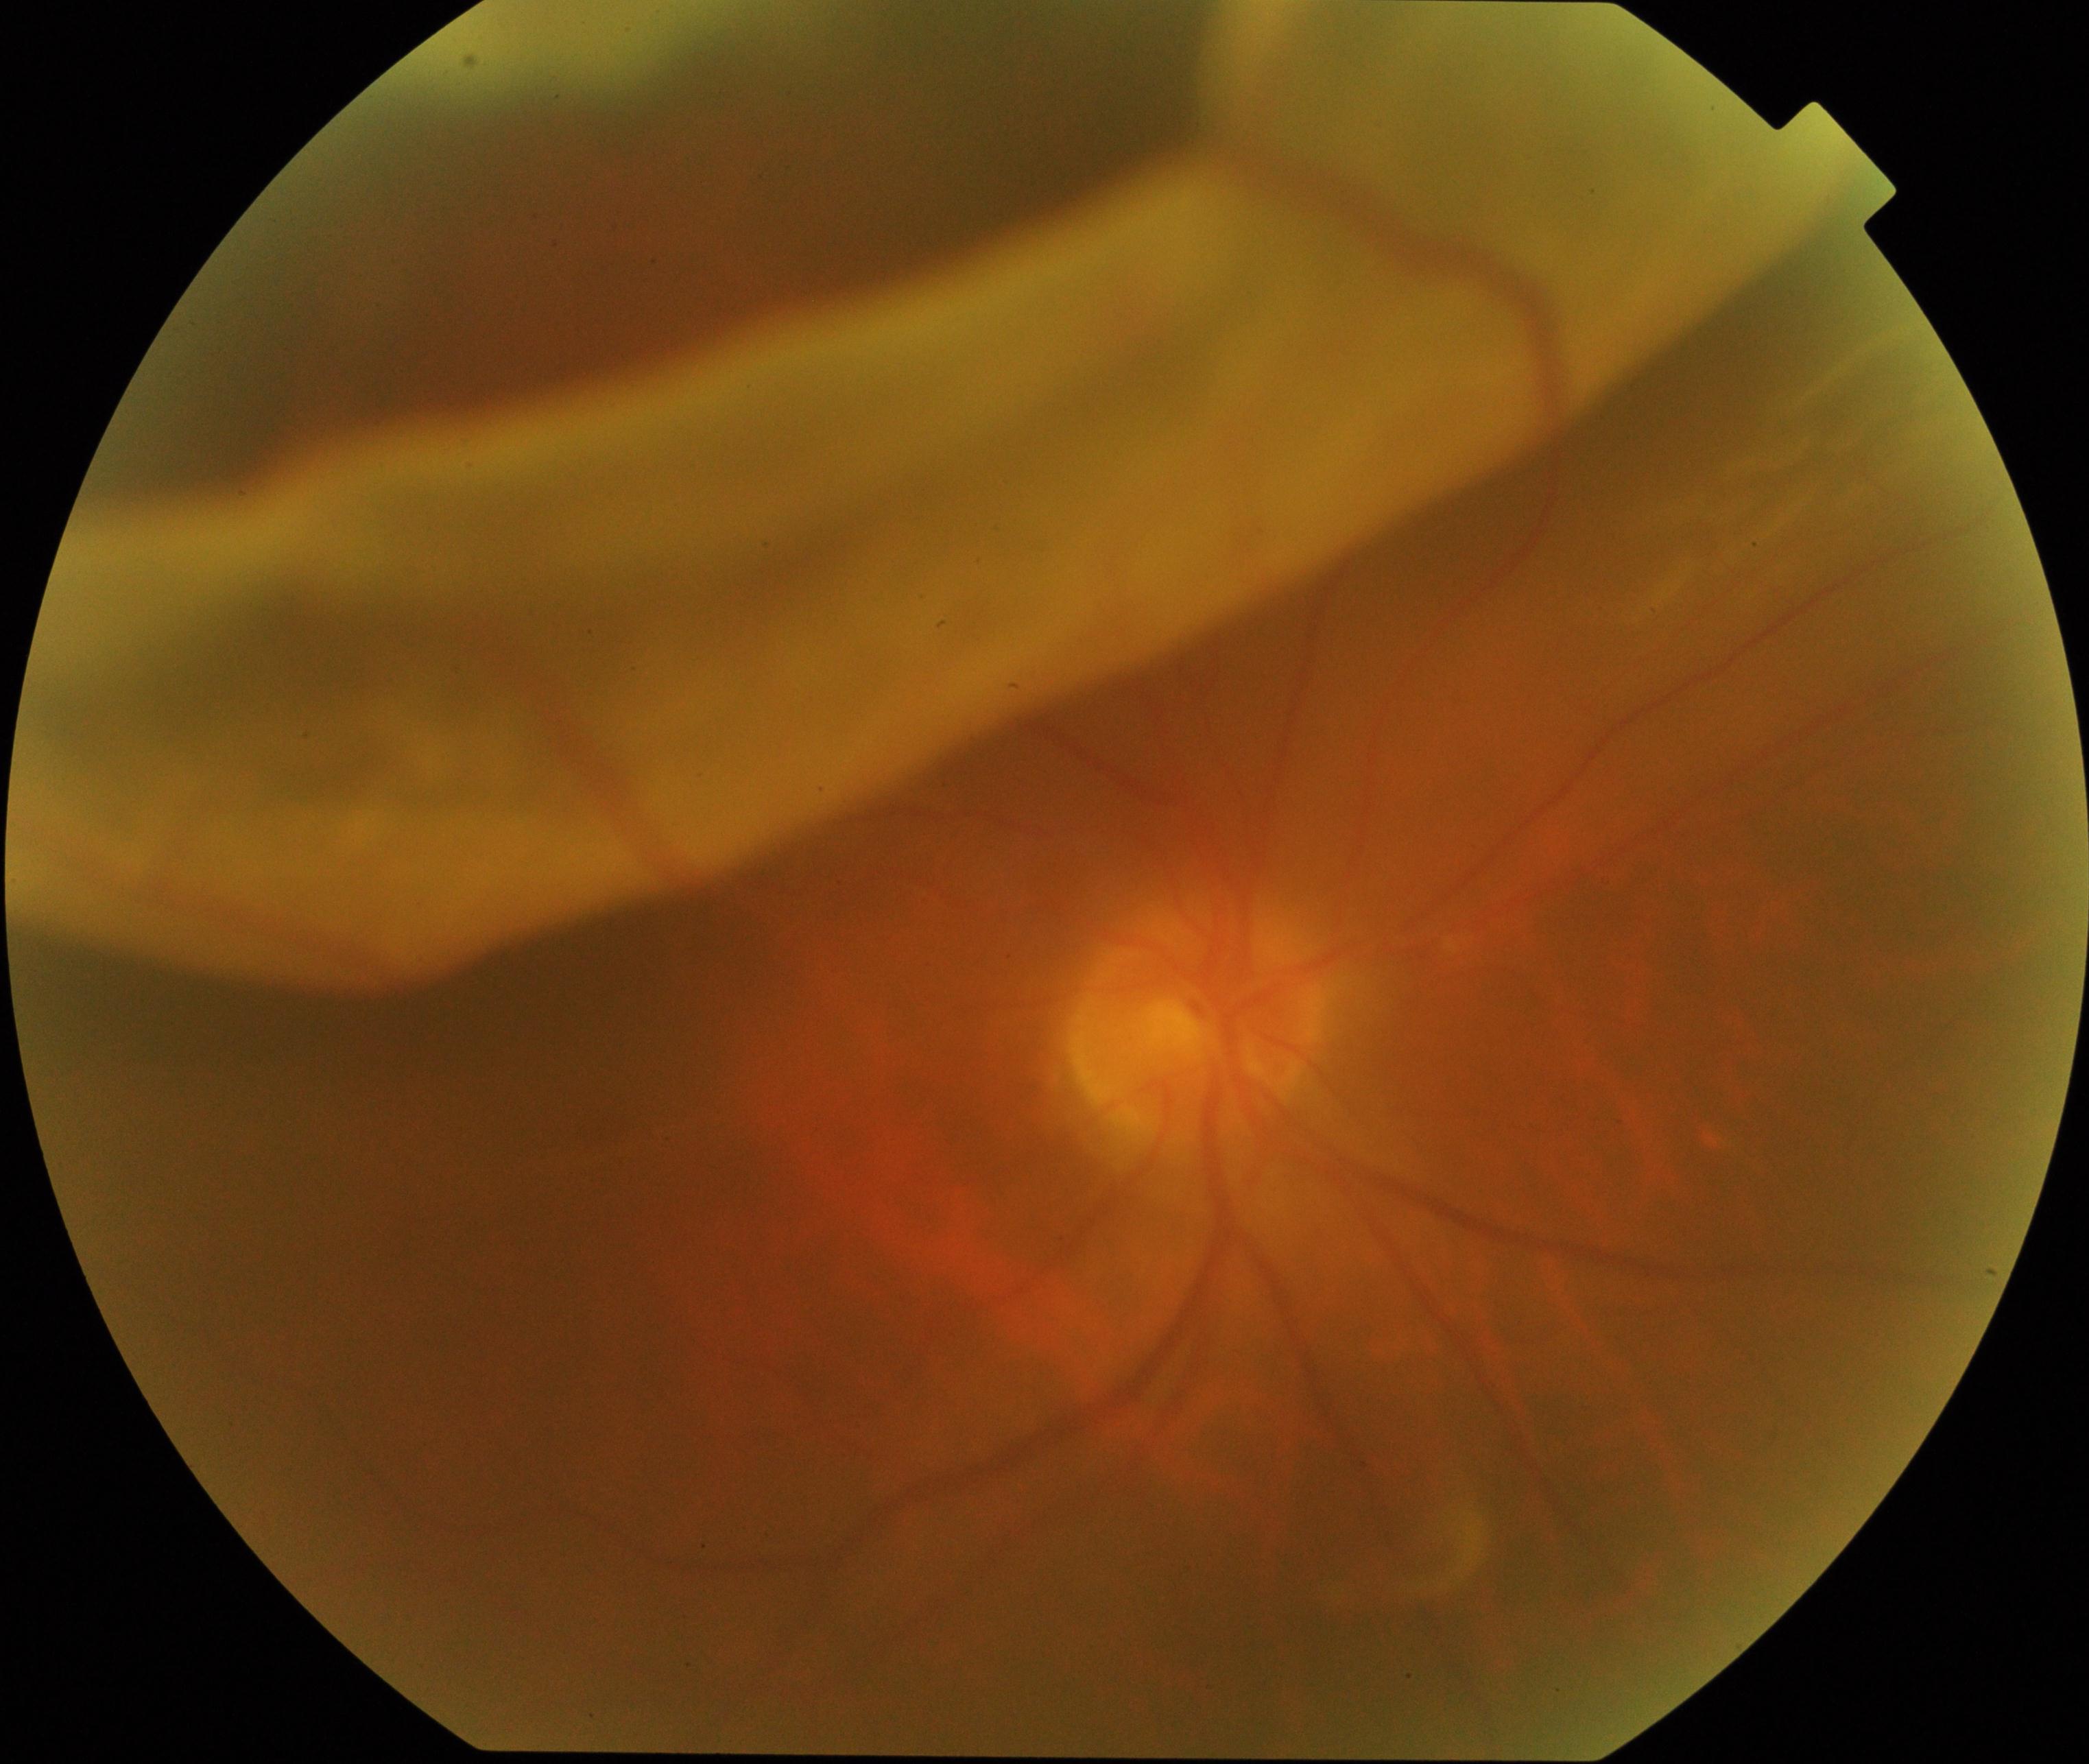

Fundus appearance consistent with rhegmatogenous retinal detachment. Characterized by slightly opaque, convex or corrugated appearance of elevated retina, sometimes with retinal breaks in view.